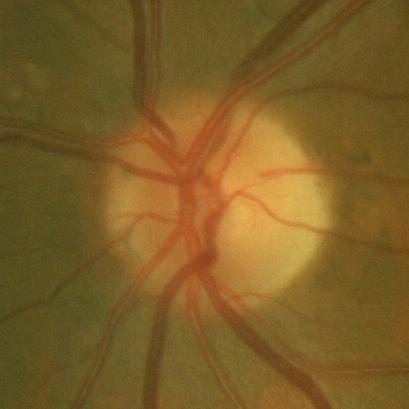
Impression = no glaucomatous damage.